No pharmacologic dilation: 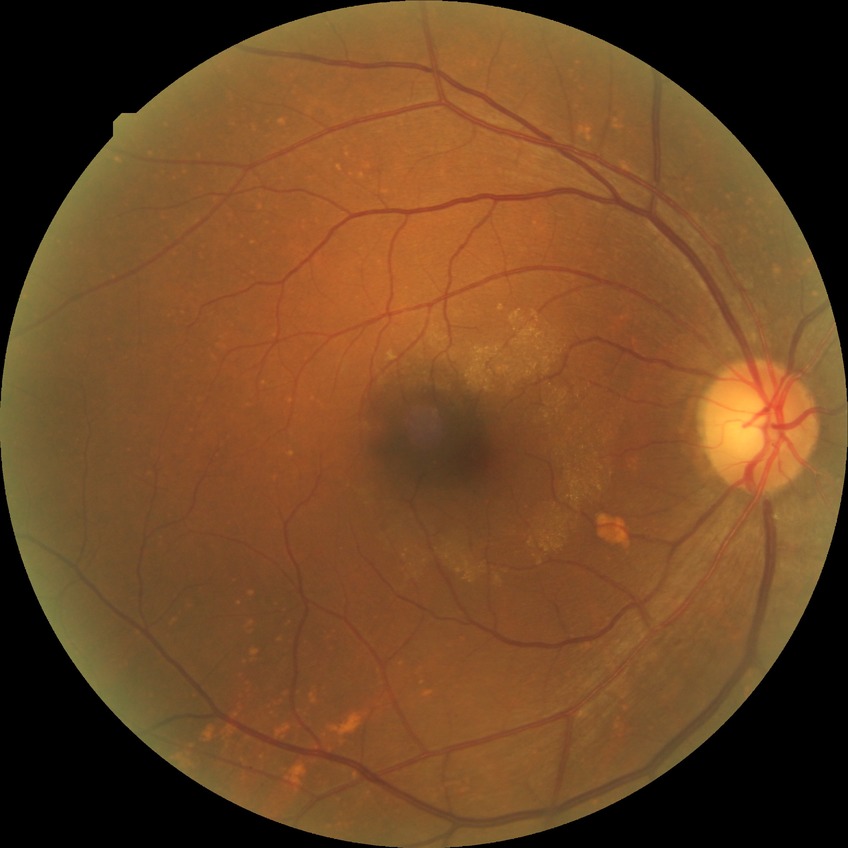

diabetic retinopathy (DR)@NDR (no diabetic retinopathy).